1380 x 1382 pixels — 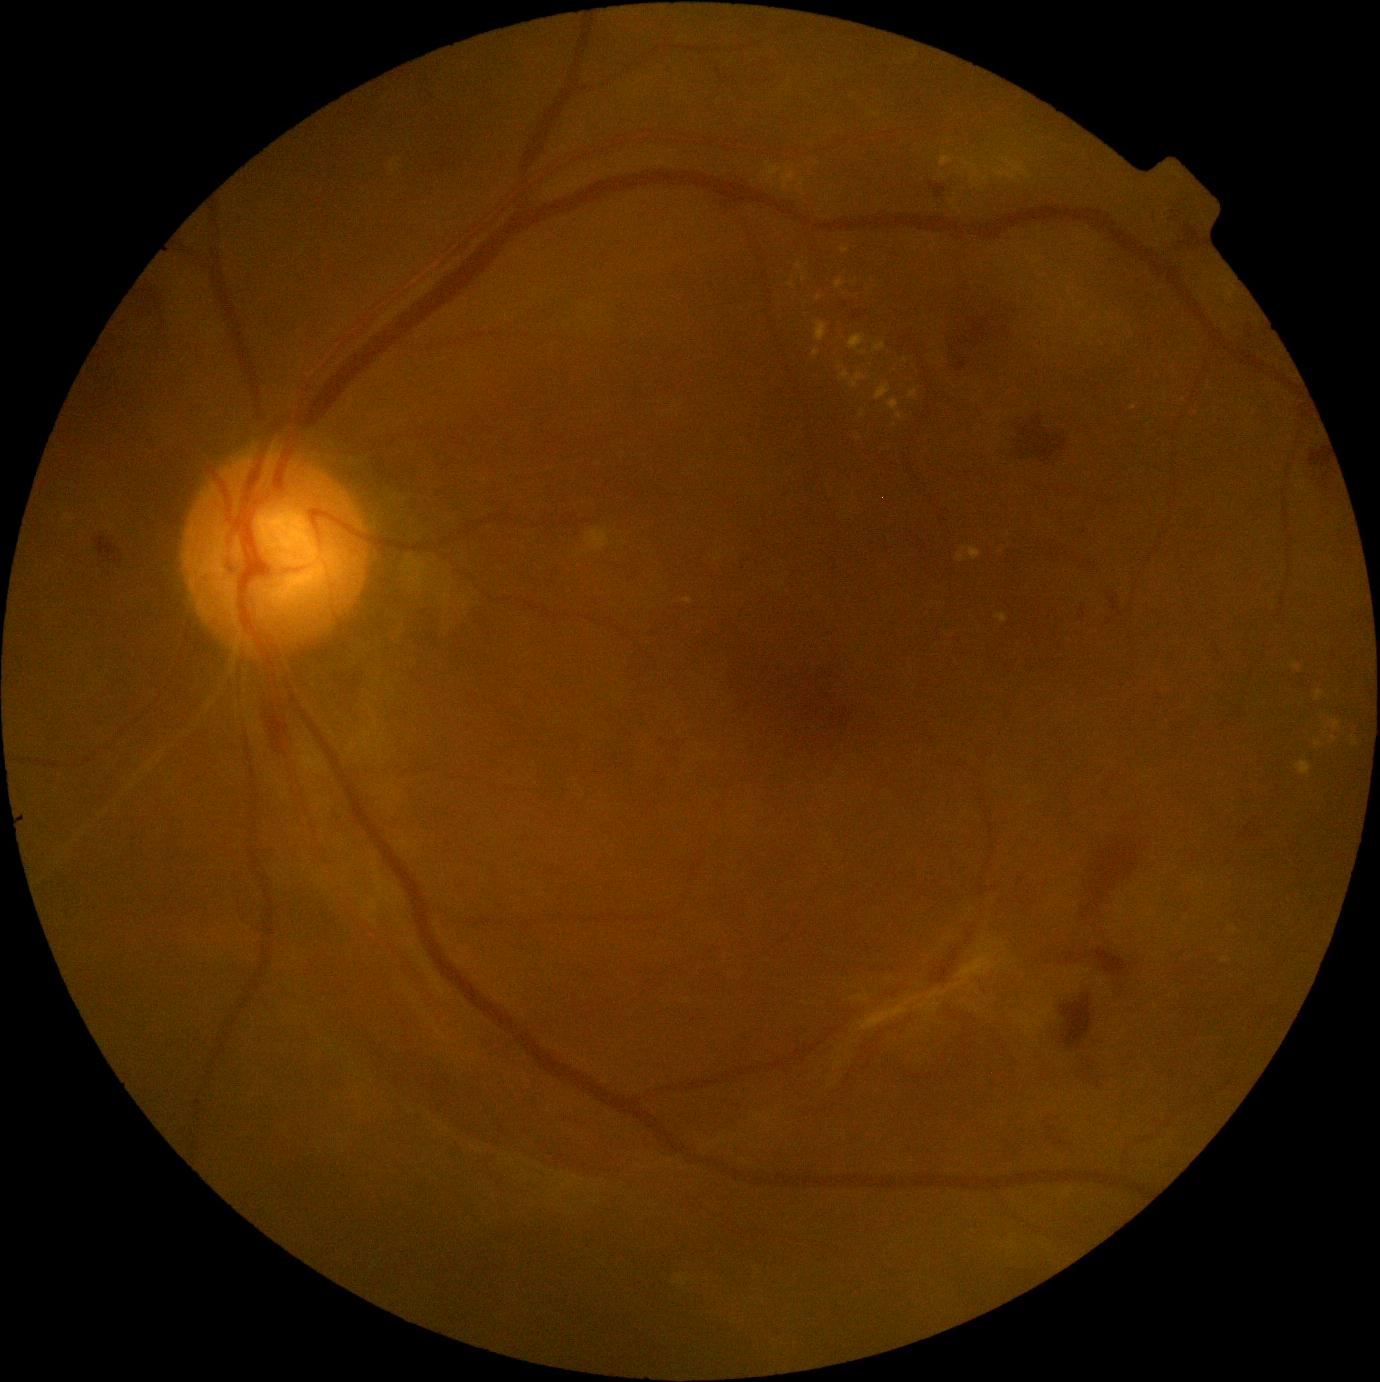
Diabetic retinopathy: grade 4 (PDR) — neovascularization and/or vitreous/pre-retinal hemorrhage
A subset of detected lesions:
hard exudates (partial): {"left": 767, "top": 167, "right": 782, "bottom": 183}; {"left": 996, "top": 614, "right": 1008, "bottom": 624}; {"left": 971, "top": 179, "right": 977, "bottom": 187}; {"left": 995, "top": 158, "right": 1033, "bottom": 181}; {"left": 874, "top": 342, "right": 886, "bottom": 353}; {"left": 860, "top": 410, "right": 866, "bottom": 418}; {"left": 797, "top": 263, "right": 806, "bottom": 271}; {"left": 1315, "top": 742, "right": 1325, "bottom": 748}; {"left": 851, "top": 373, "right": 866, "bottom": 388}; {"left": 1292, "top": 663, "right": 1302, "bottom": 672}; {"left": 957, "top": 547, "right": 967, "bottom": 563}
Smaller hard exudates around 1335/739; 988/169; 1225/961; 1235/930
soft exudates: none identified
hemorrhages: {"left": 945, "top": 303, "right": 1015, "bottom": 368}; {"left": 1095, "top": 949, "right": 1132, "bottom": 976}; {"left": 1182, "top": 221, "right": 1204, "bottom": 240}; {"left": 930, "top": 183, "right": 946, "bottom": 198}; {"left": 996, "top": 415, "right": 1065, "bottom": 462}; {"left": 1081, "top": 835, "right": 1143, "bottom": 920}; {"left": 1061, "top": 995, "right": 1093, "bottom": 1049}; {"left": 261, "top": 698, "right": 282, "bottom": 764}; {"left": 94, "top": 529, "right": 125, "bottom": 567}; {"left": 716, "top": 194, "right": 744, "bottom": 206}; {"left": 1311, "top": 446, "right": 1331, "bottom": 497}
microaneurysms: none identified